Nonmydriatic, graded on the modified Davis scale
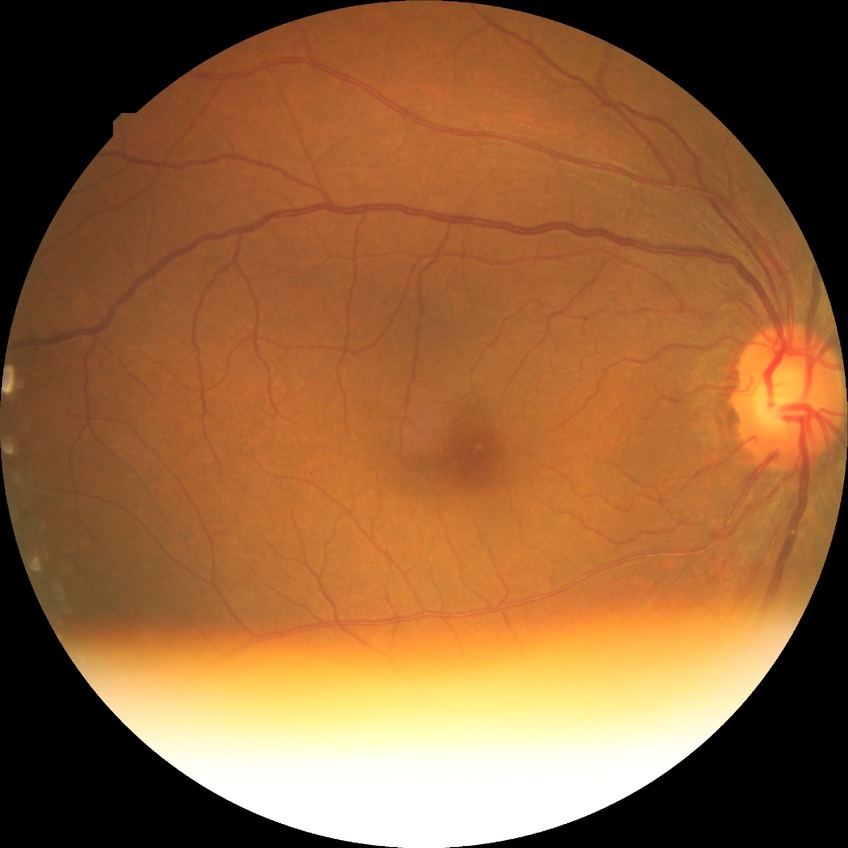
Davis DR grade: NDR.